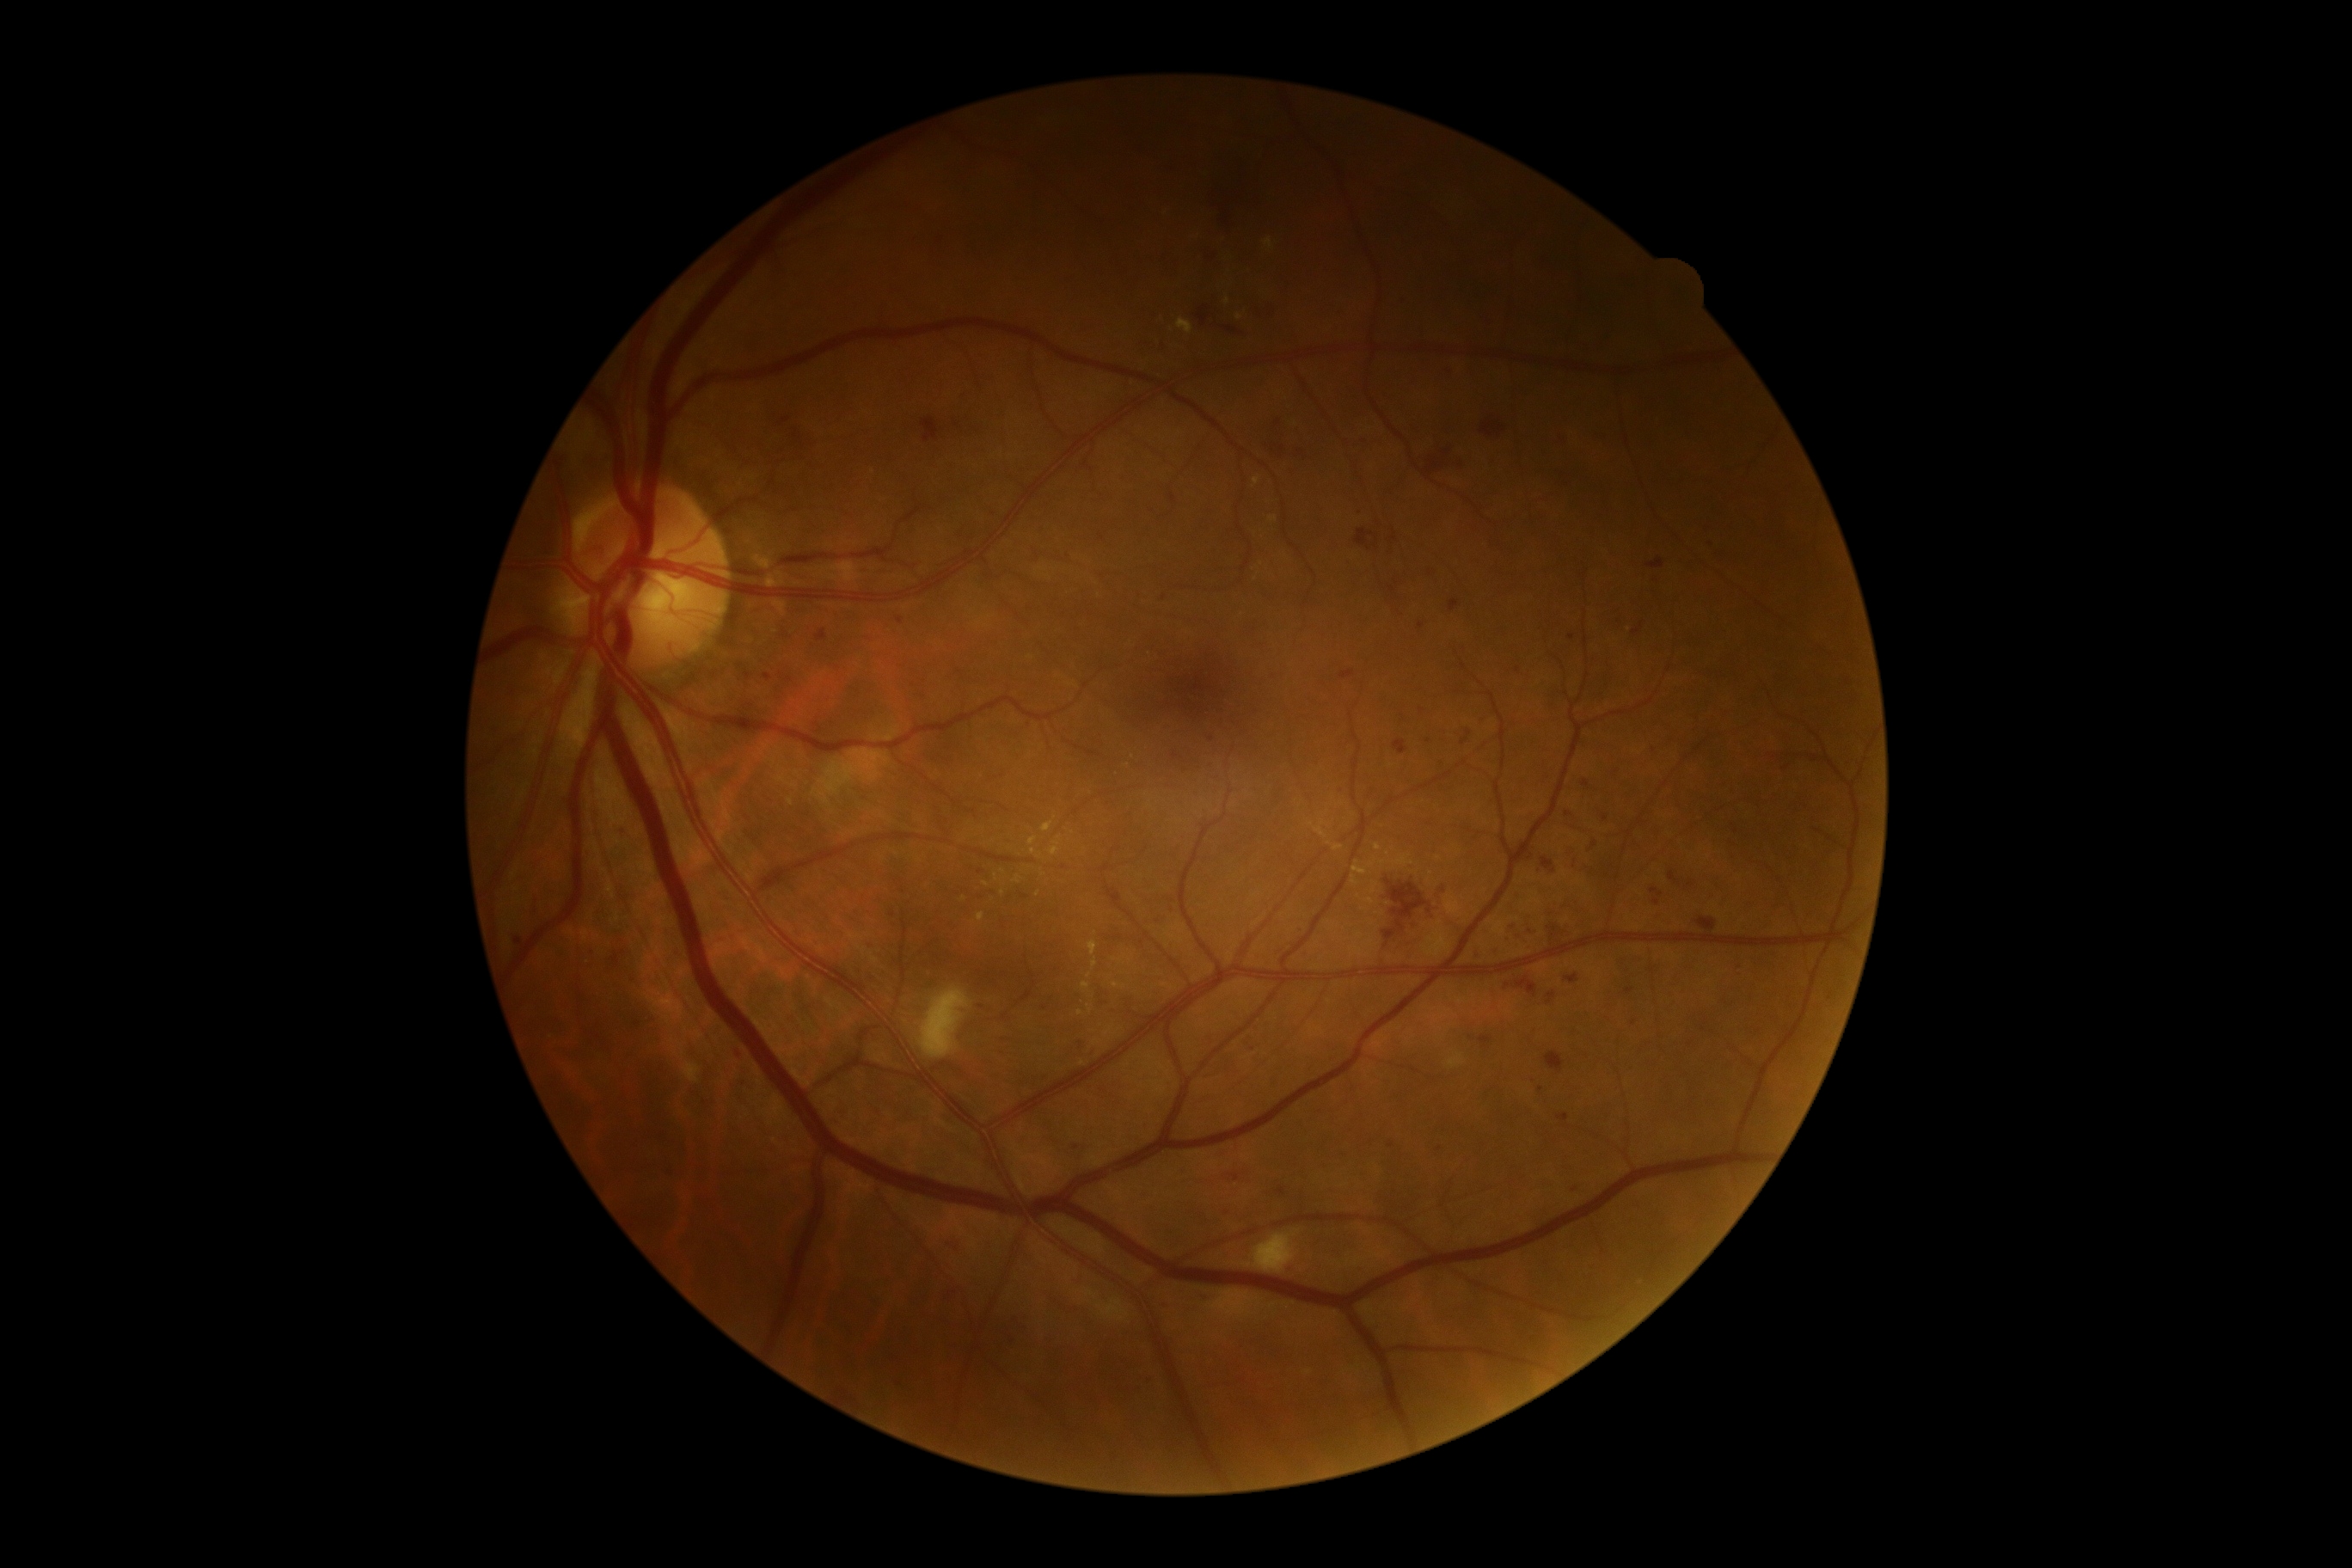

Diabetic retinopathy (DR): grade 3 (severe NPDR).